Intraocular pressure (IOP): 11 mmHg · refractive error: +1.25 -2 × 80° · central corneal thickness 488 µm.
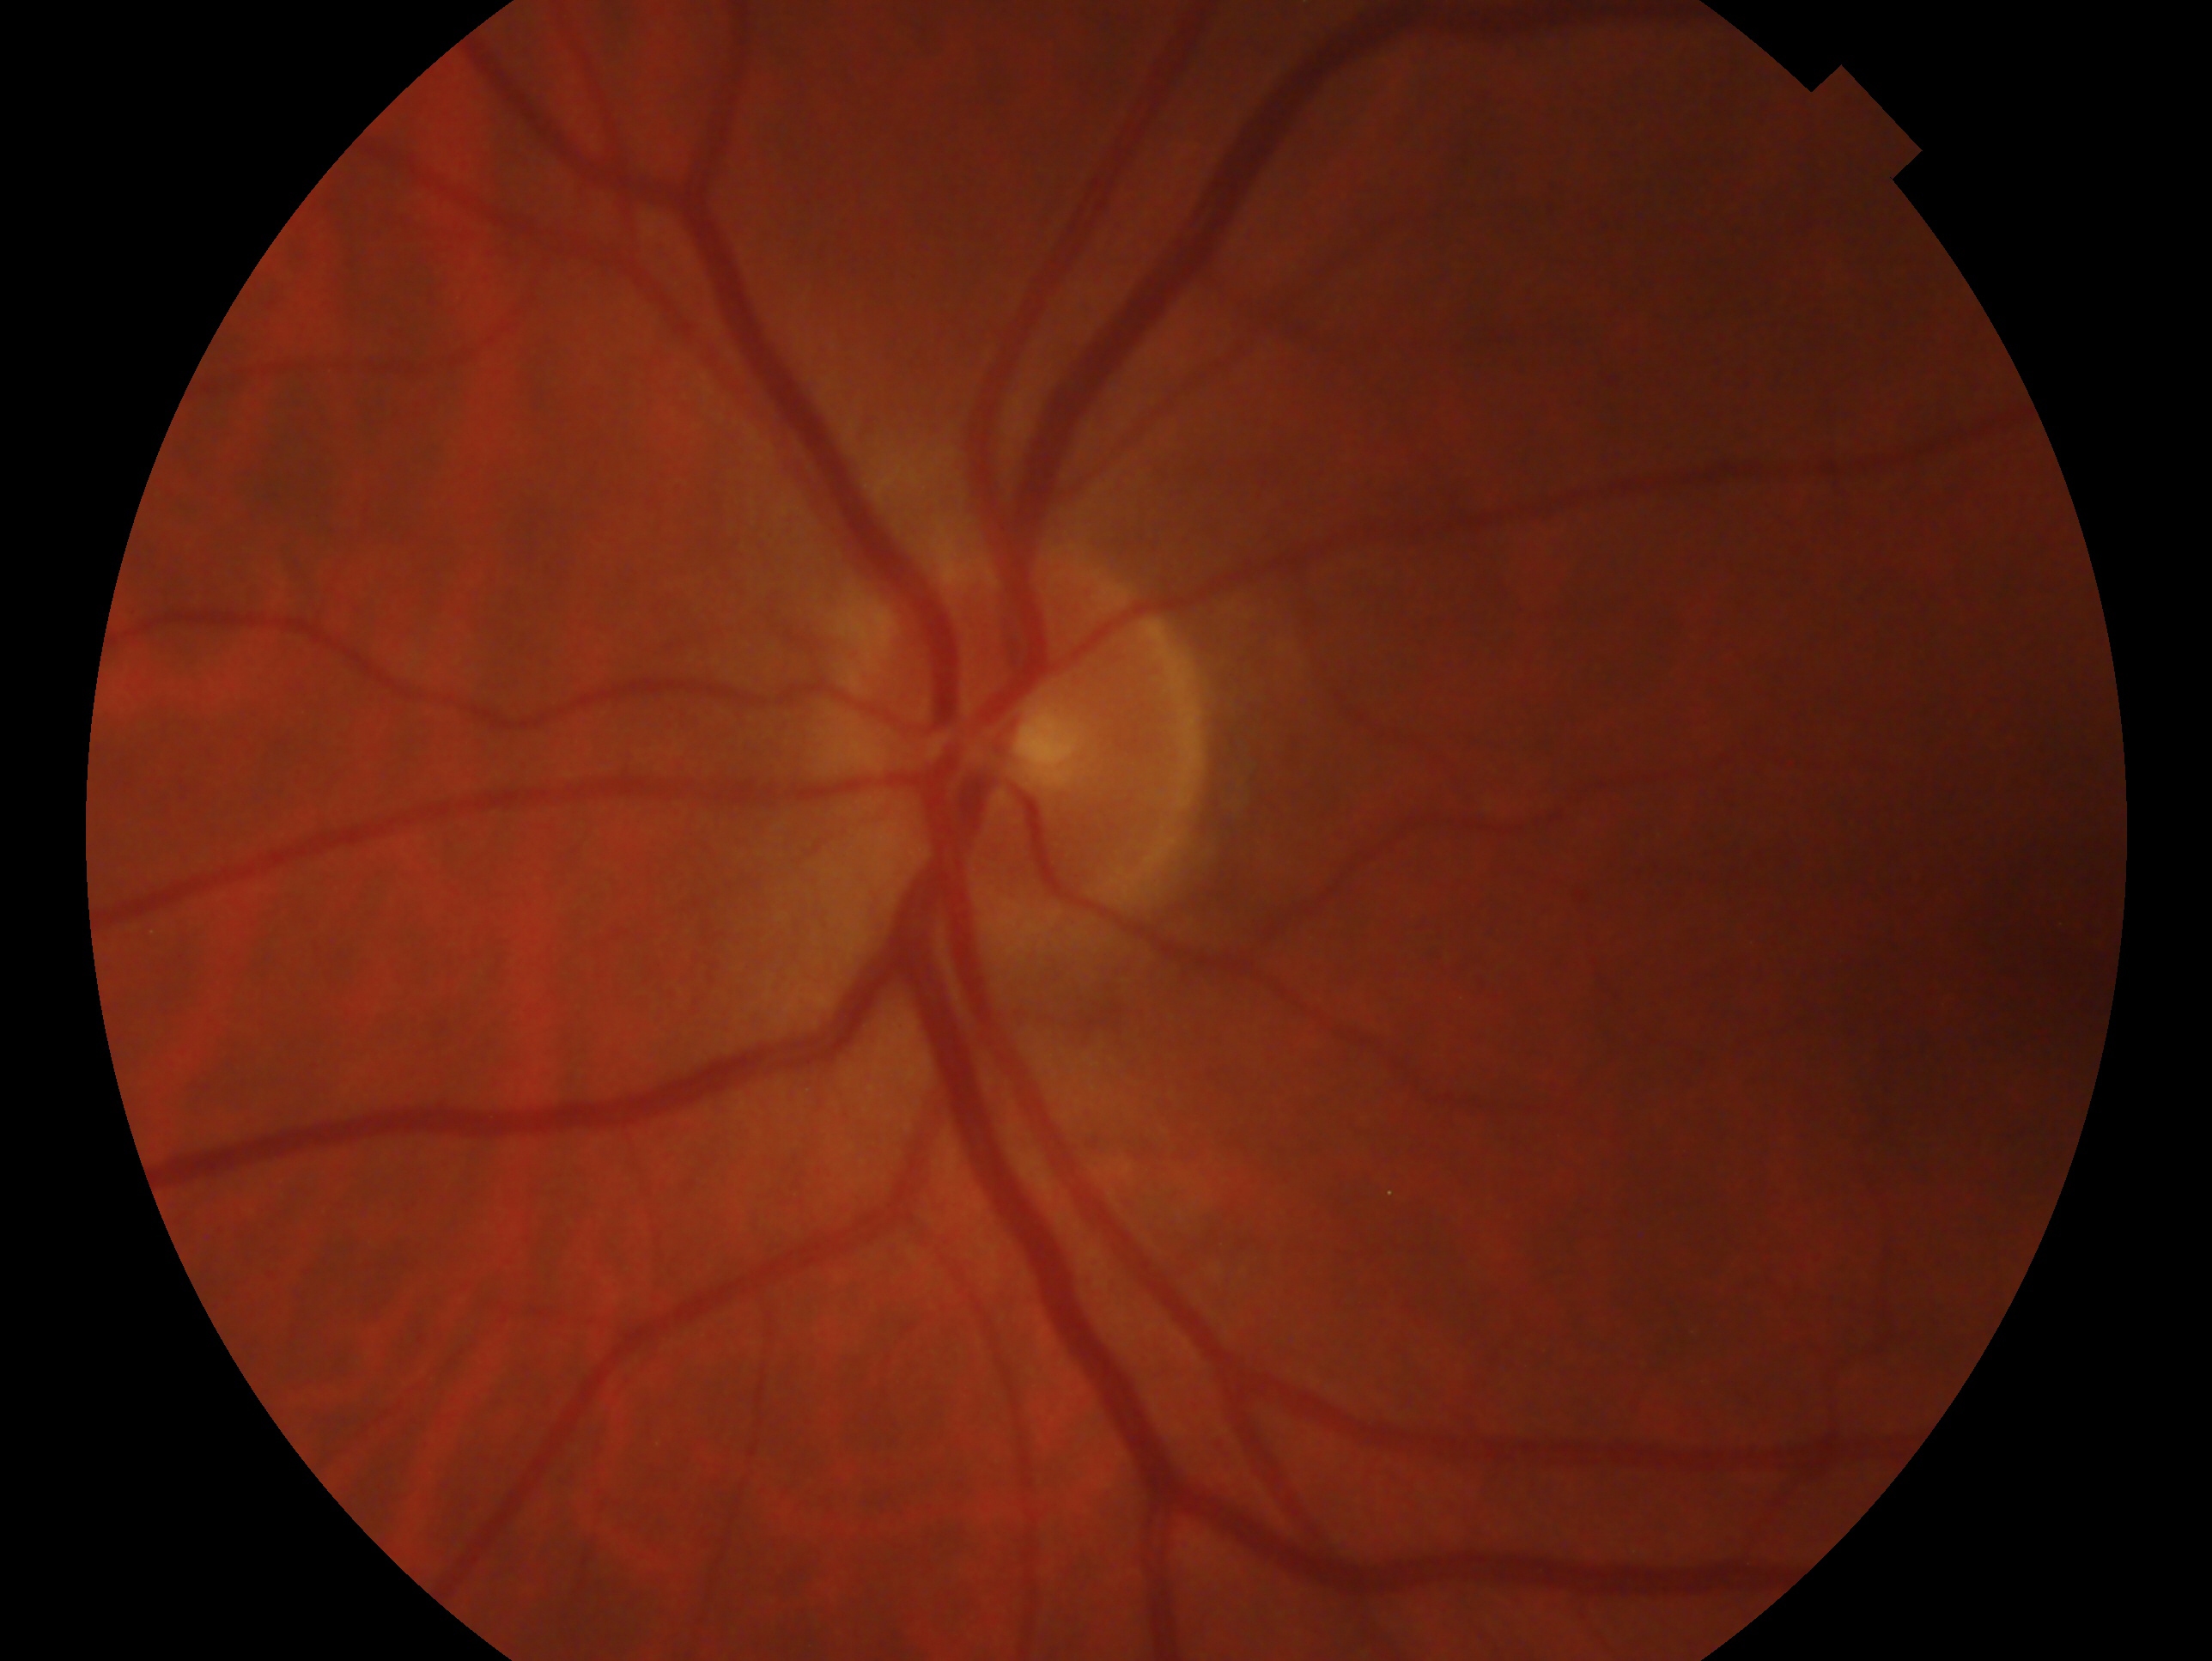

The image shows the left eye.
Glaucoma diagnosis: no signs of glaucoma — no clinical evidence of glaucoma in this eye.